Optic disc-centered crop from a color fundus photograph
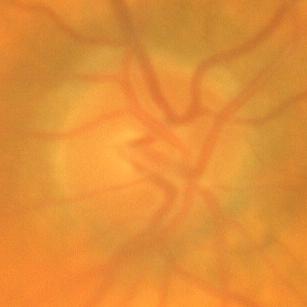
Findings consistent with no glaucomatous optic neuropathy.